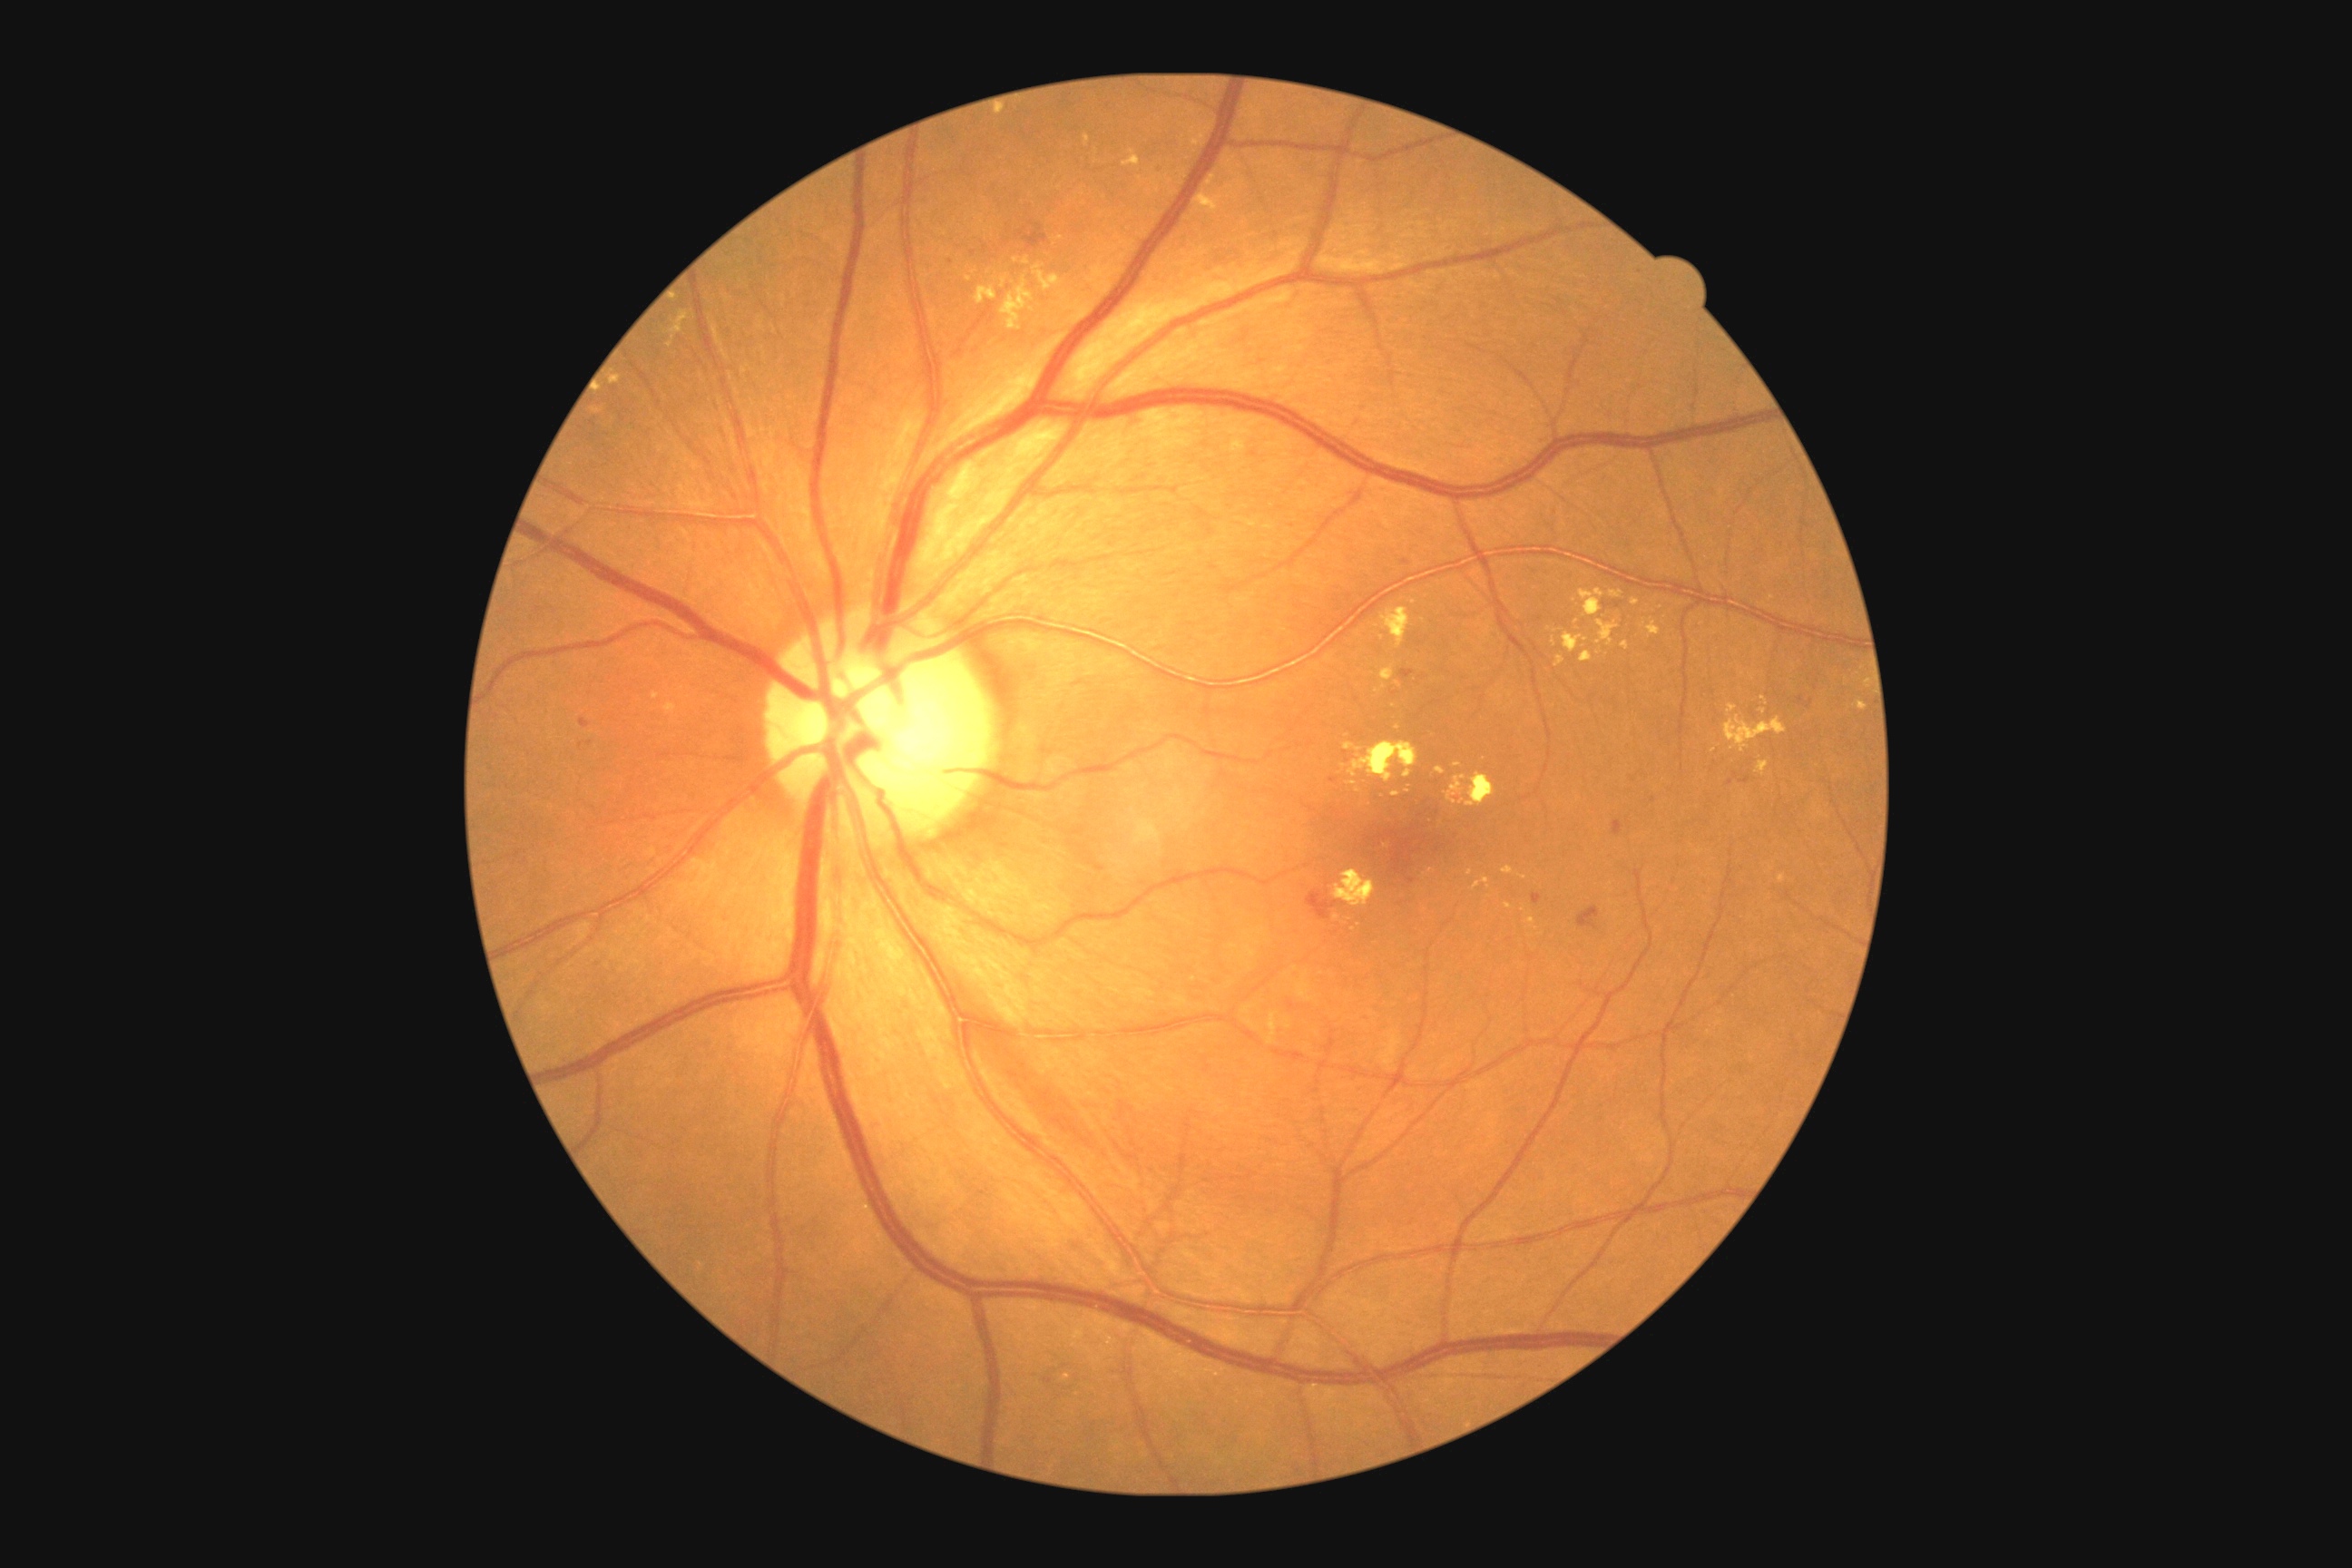

{"partial": true, "dr_grade": 2, "dr_grade_name": "moderate NPDR", "lesions": {"he": [[580, 718, 591, 729], [1808, 700, 1814, 709], [1453, 794, 1464, 801], [1017, 222, 1048, 250], [985, 244, 988, 255], [1612, 819, 1625, 838], [1732, 772, 1740, 779], [1407, 879, 1415, 885]], "he_small": [[1346, 754], [1634, 779], [1619, 605], [951, 263], [1356, 699], [1729, 784]], "ex": [[1611, 591, 1623, 598], [1380, 609, 1409, 649], [1580, 589, 1605, 618], [1727, 705, 1738, 716], [652, 692, 660, 700], [1380, 665, 1395, 681], [1725, 716, 1787, 752], [1553, 638, 1556, 647], [1563, 632, 1589, 654], [1518, 874, 1527, 879], [1344, 743, 1362, 752], [1631, 598, 1640, 607], [1779, 874, 1787, 885]], "ex_small": [[1574, 600], [1032, 309], [1016, 260], [1385, 846], [1457, 766]]}}